Image size 848x848, without pupil dilation
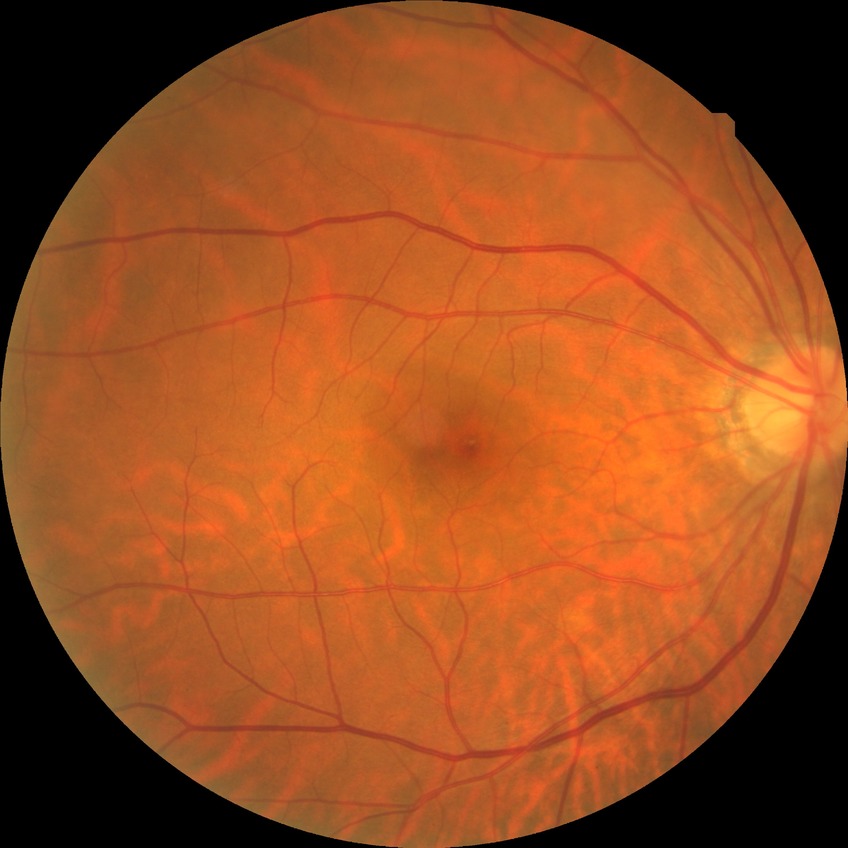
- diabetic retinopathy (DR): NDR (no diabetic retinopathy)